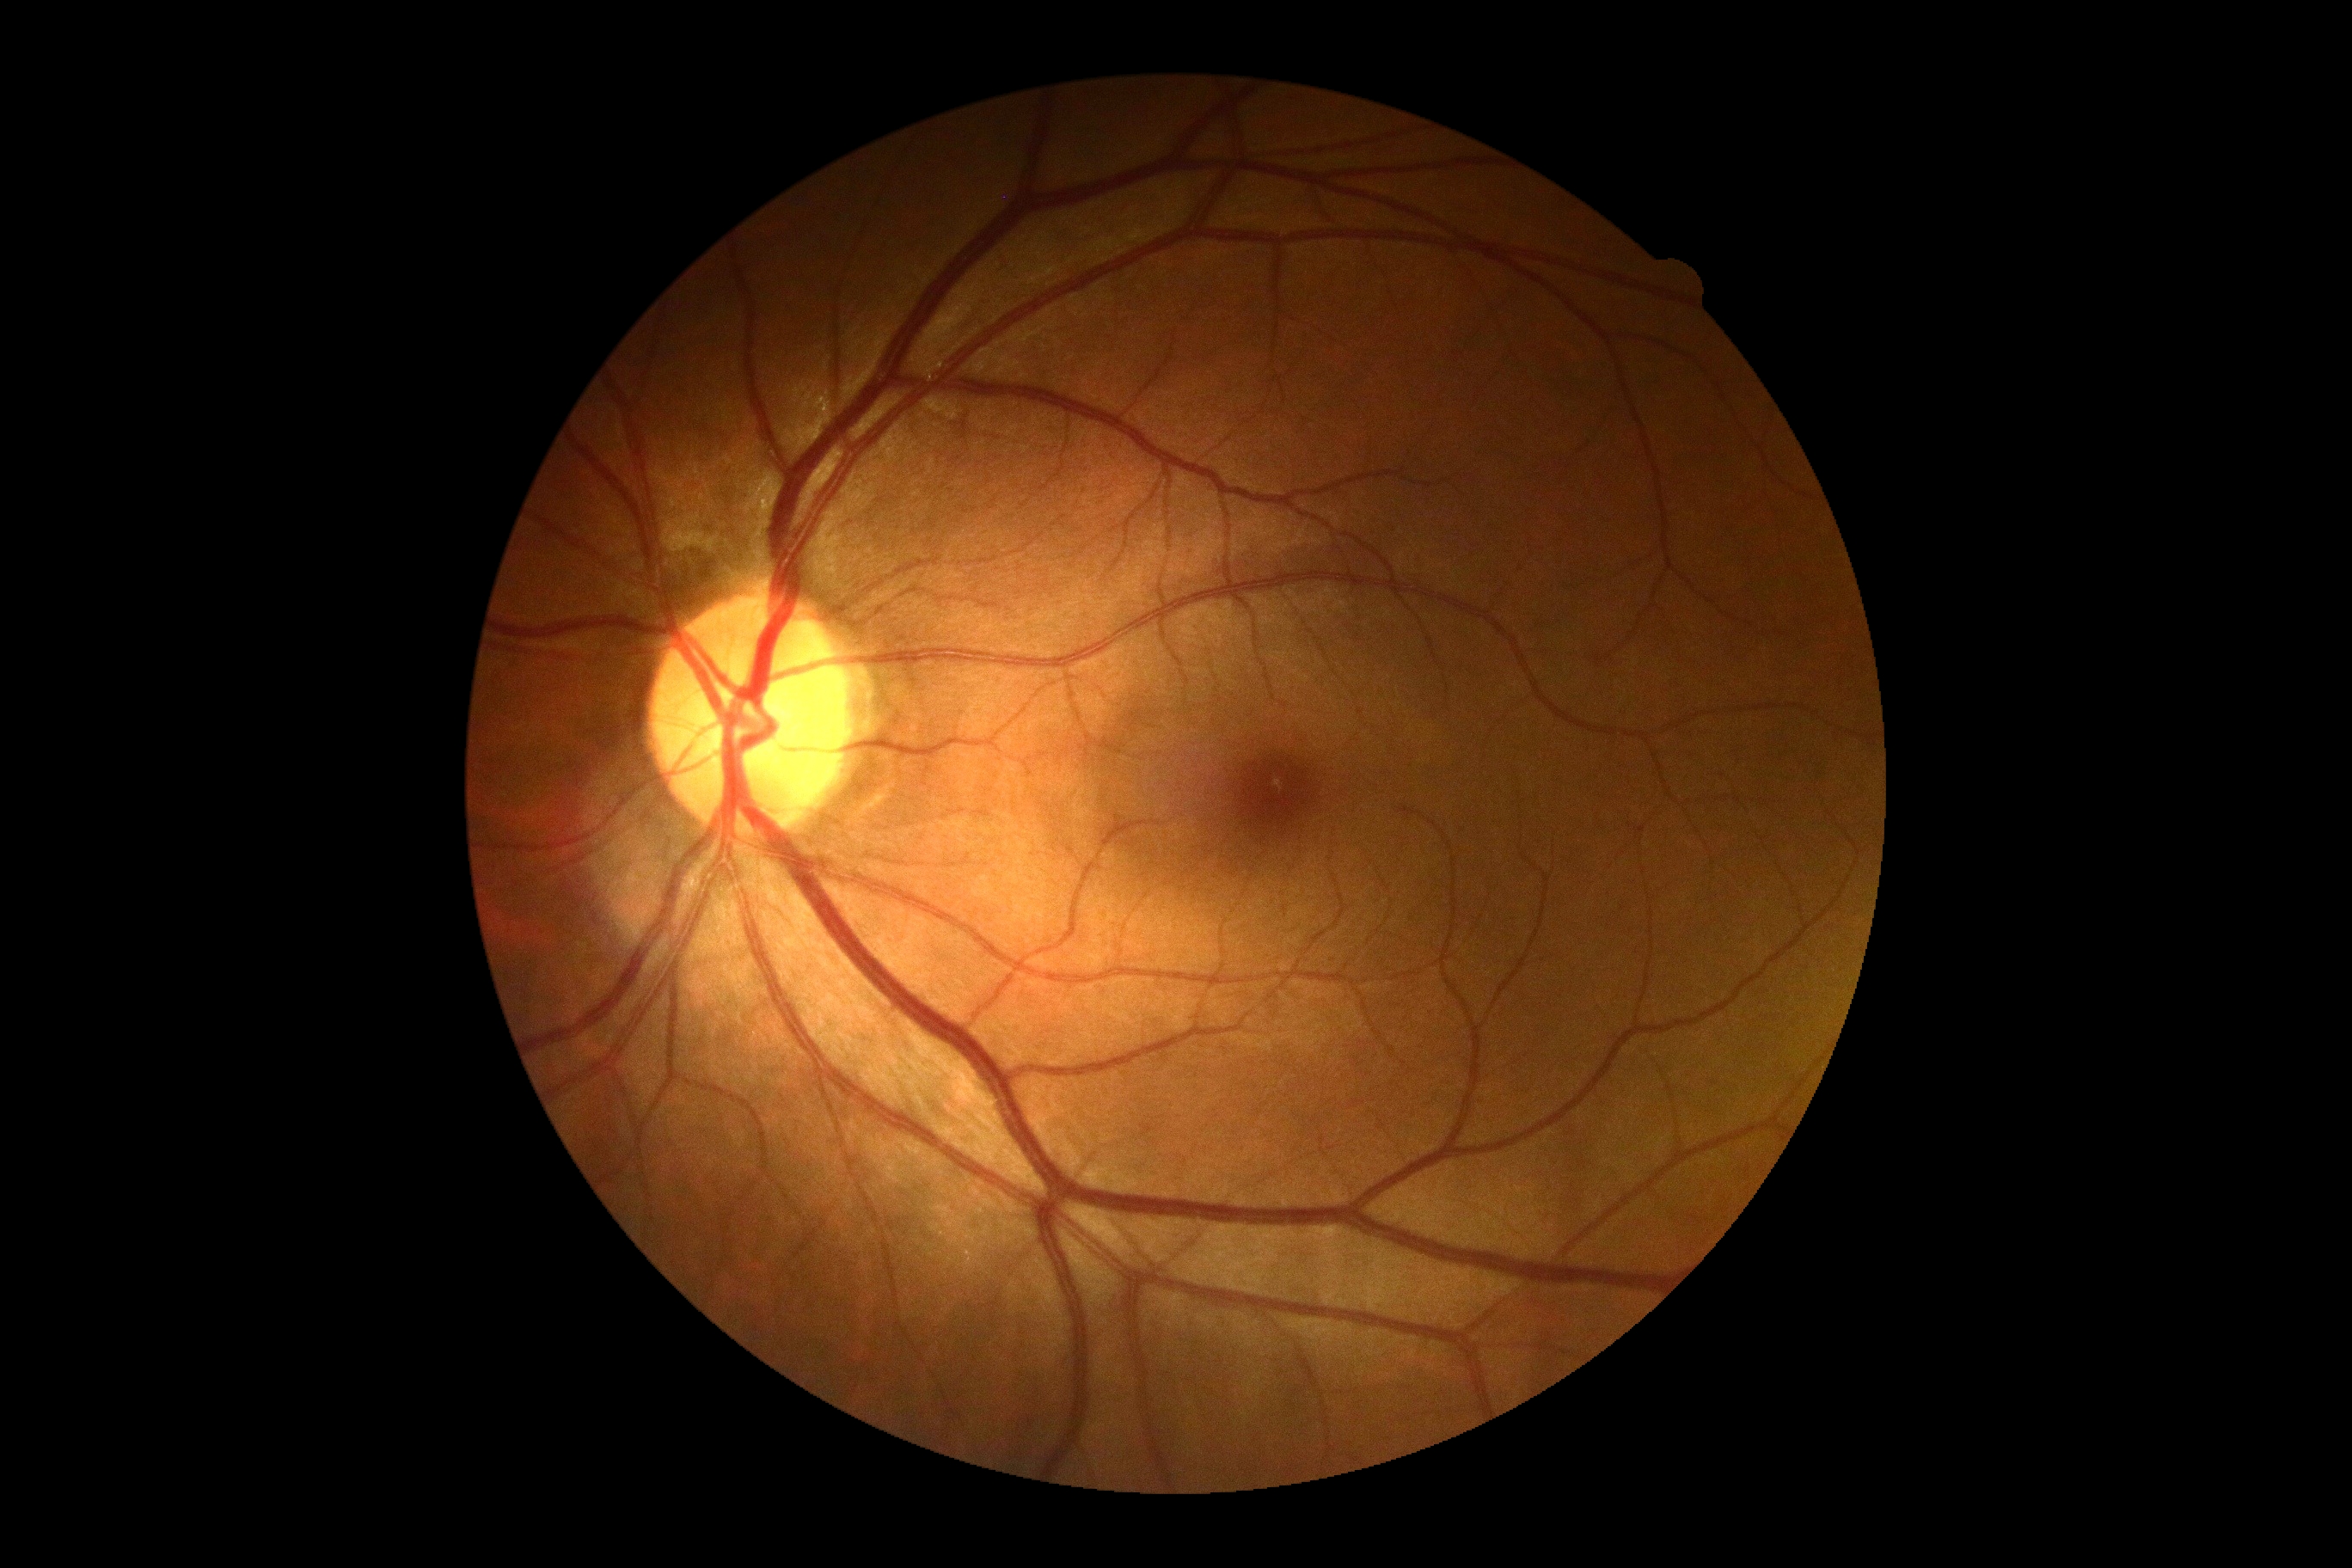
DR impression: negative for DR | diabetic retinopathy (DR): no apparent retinopathy (grade 0) — no visible signs of diabetic retinopathy.